Diabetic retinopathy graded by the modified Davis classification — 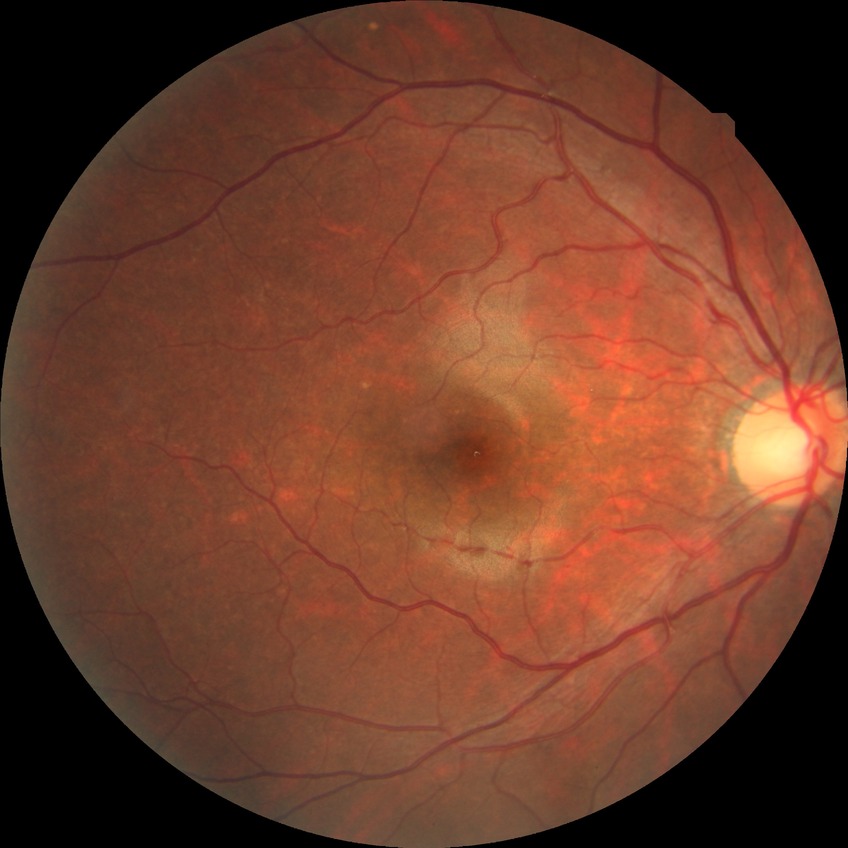 diabetic retinopathy (DR) = NDR (no diabetic retinopathy)